Topcon TRC-NW8. Macula-centered field.
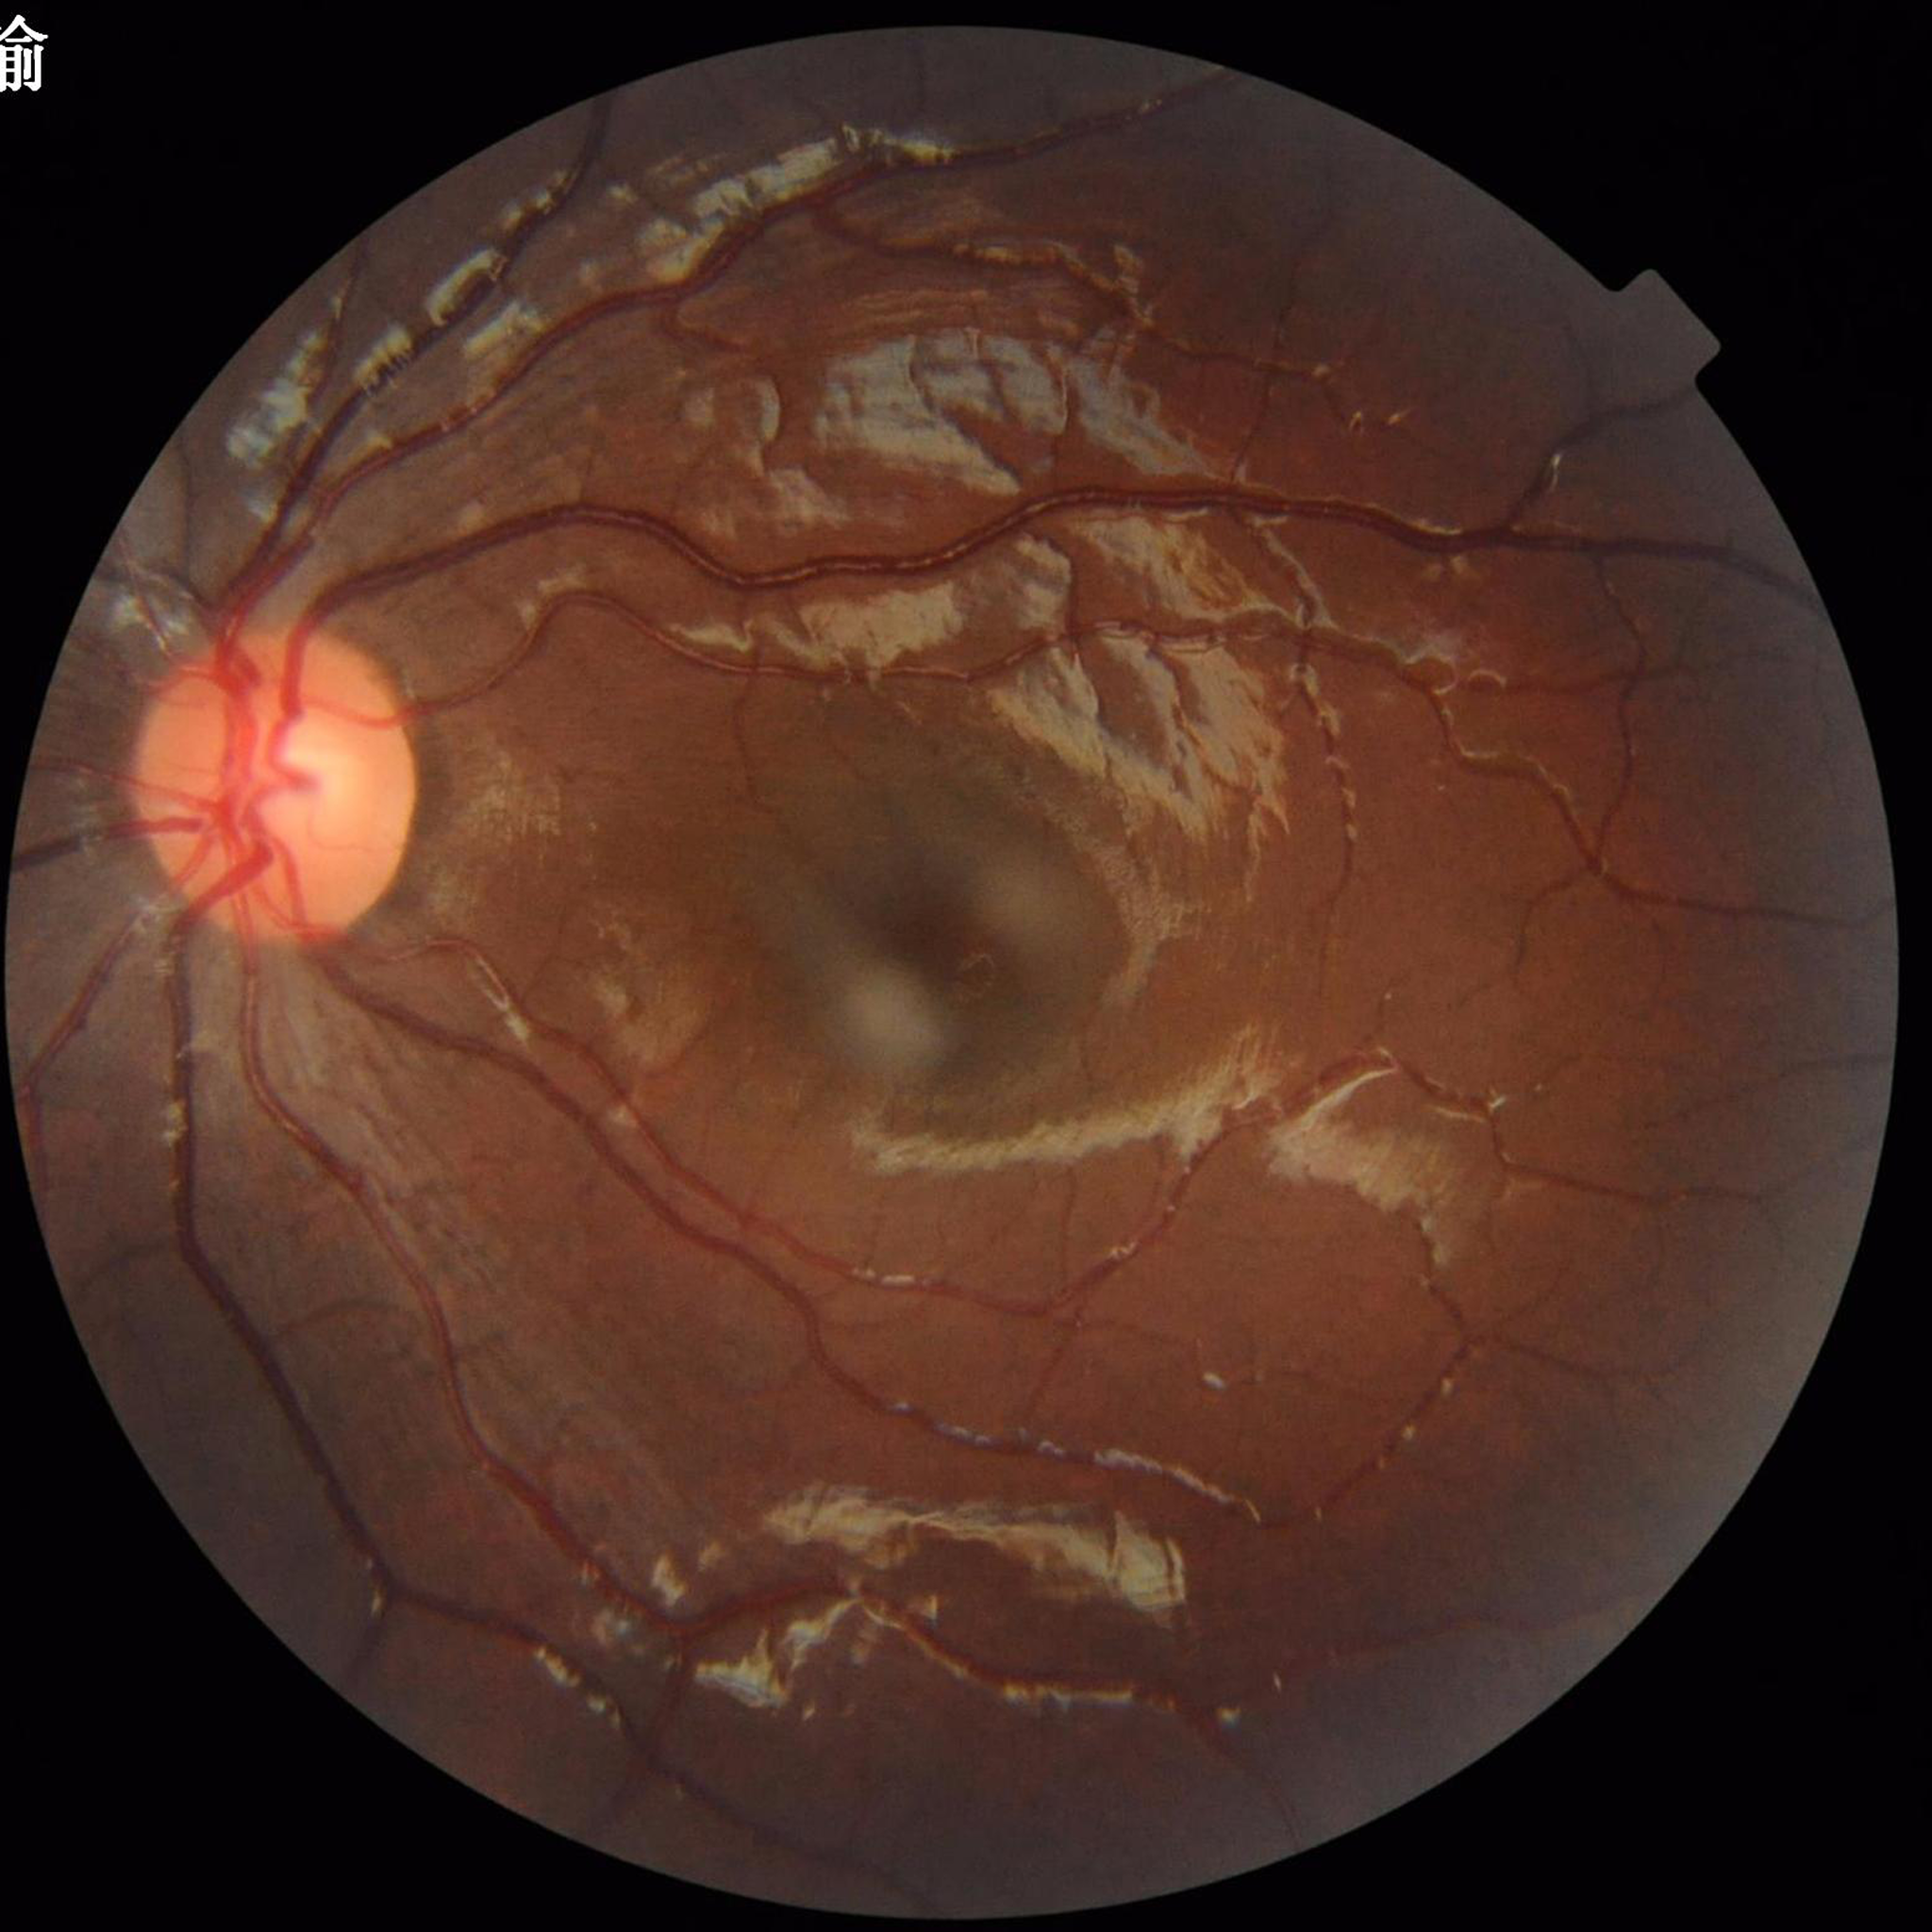
Diagnosis: no AMD, DR, or glaucomatous findings | Automated quality assessment: suboptimal — illumination/color distortion.